Camera: Natus RetCam Envision (130° FOV) · 1440x1080 · infant wide-field fundus photograph.
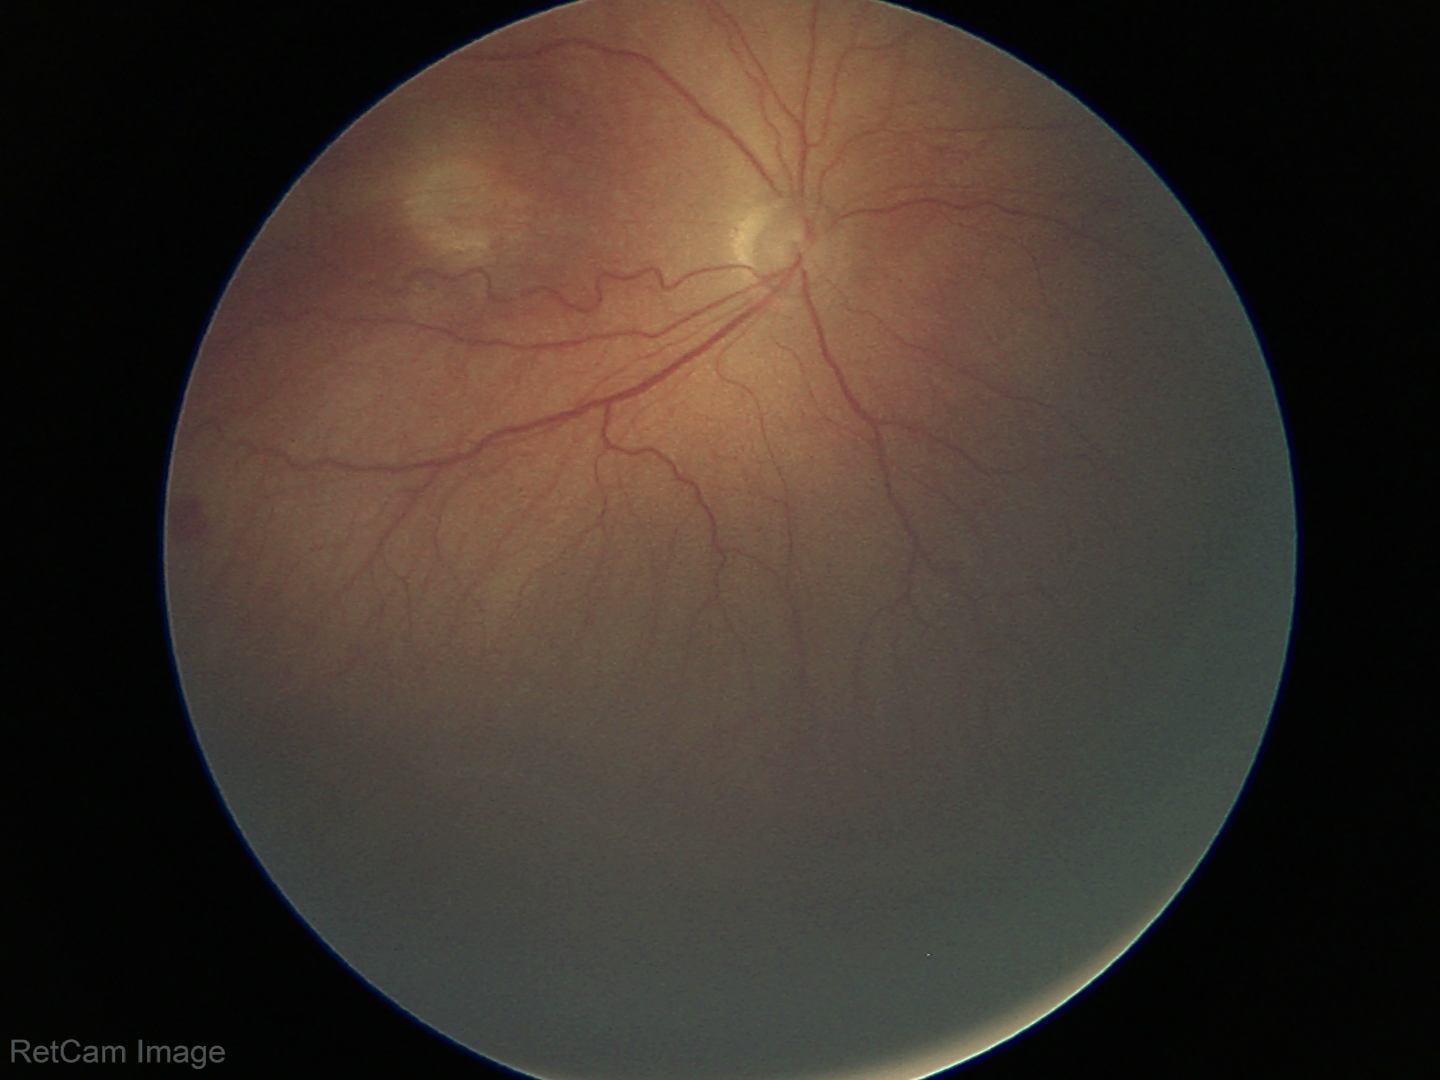 No plus disease. Examination diagnosed as retinopathy of prematurity stage 3.